FOV: 45 degrees
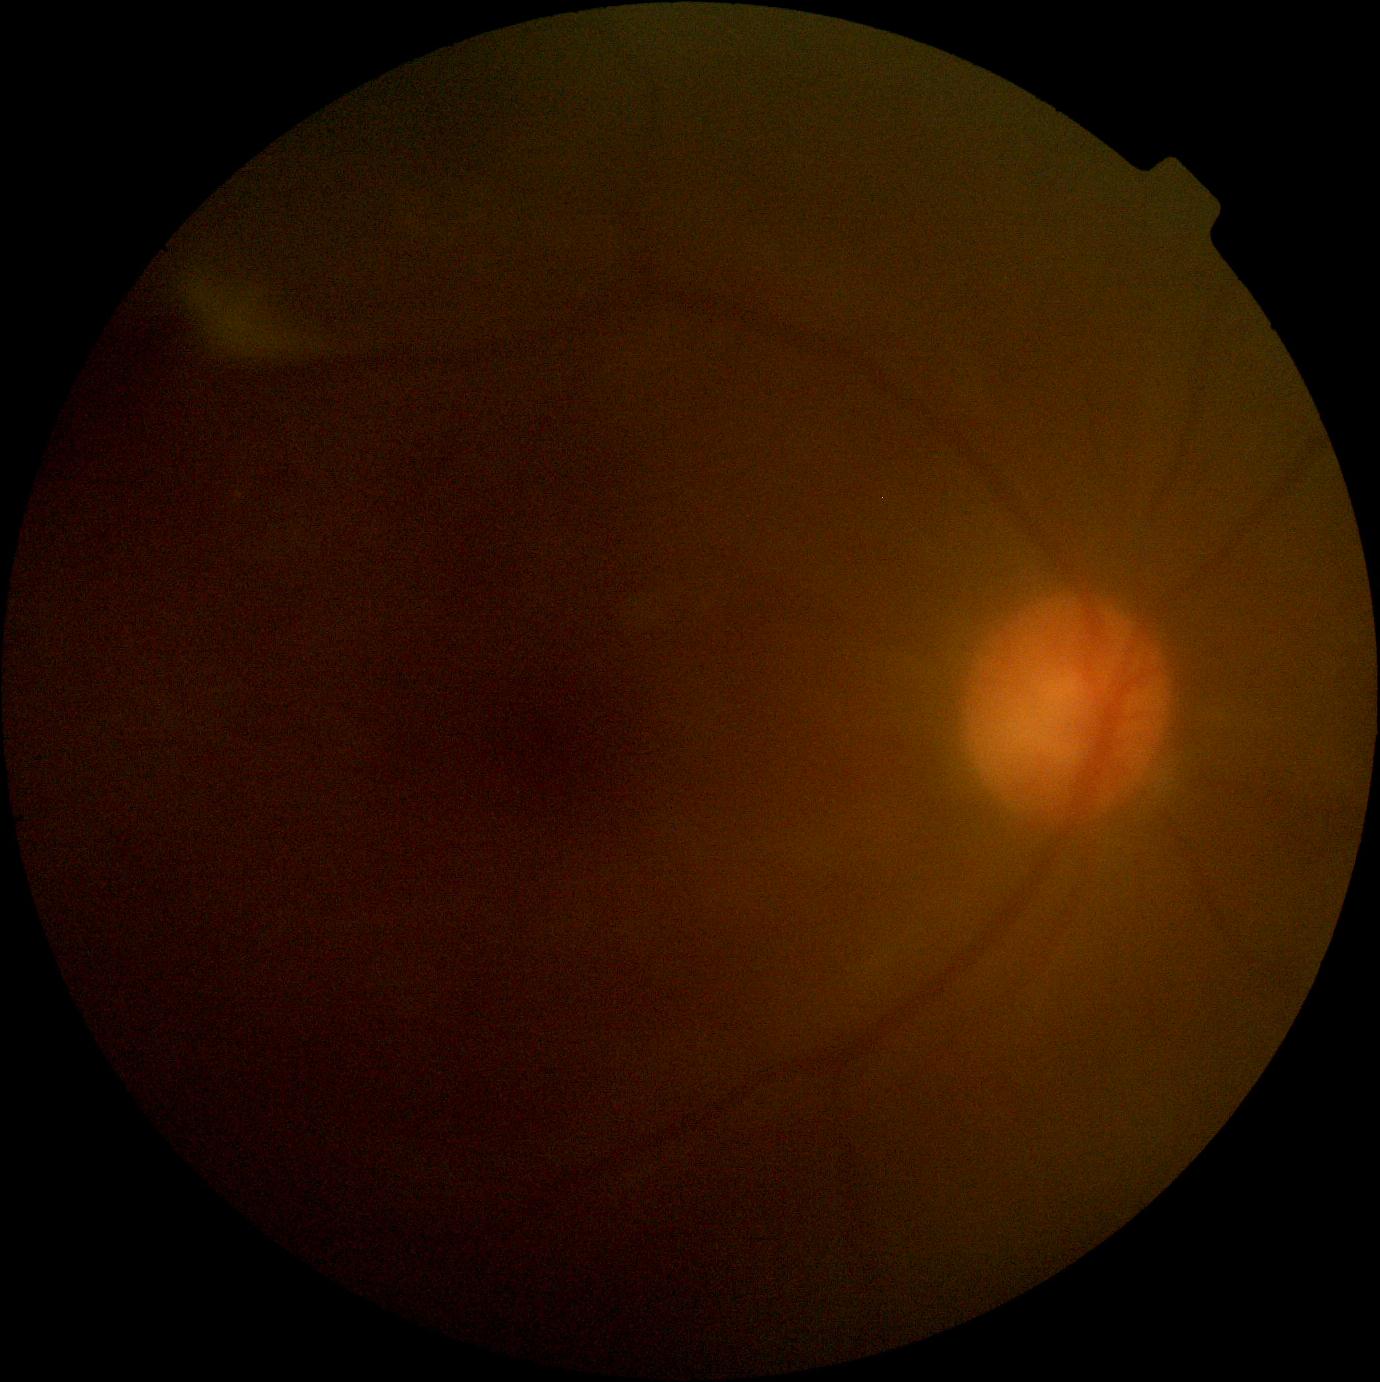
diabetic retinopathy = ungradable due to poor image quality | image quality = insufficient for DR assessment.